Wide-field fundus photograph of an infant
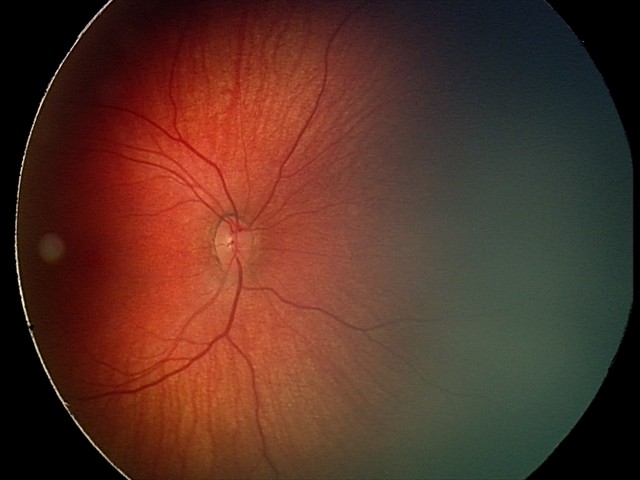
Screening examination consistent with retinal hemorrhages.